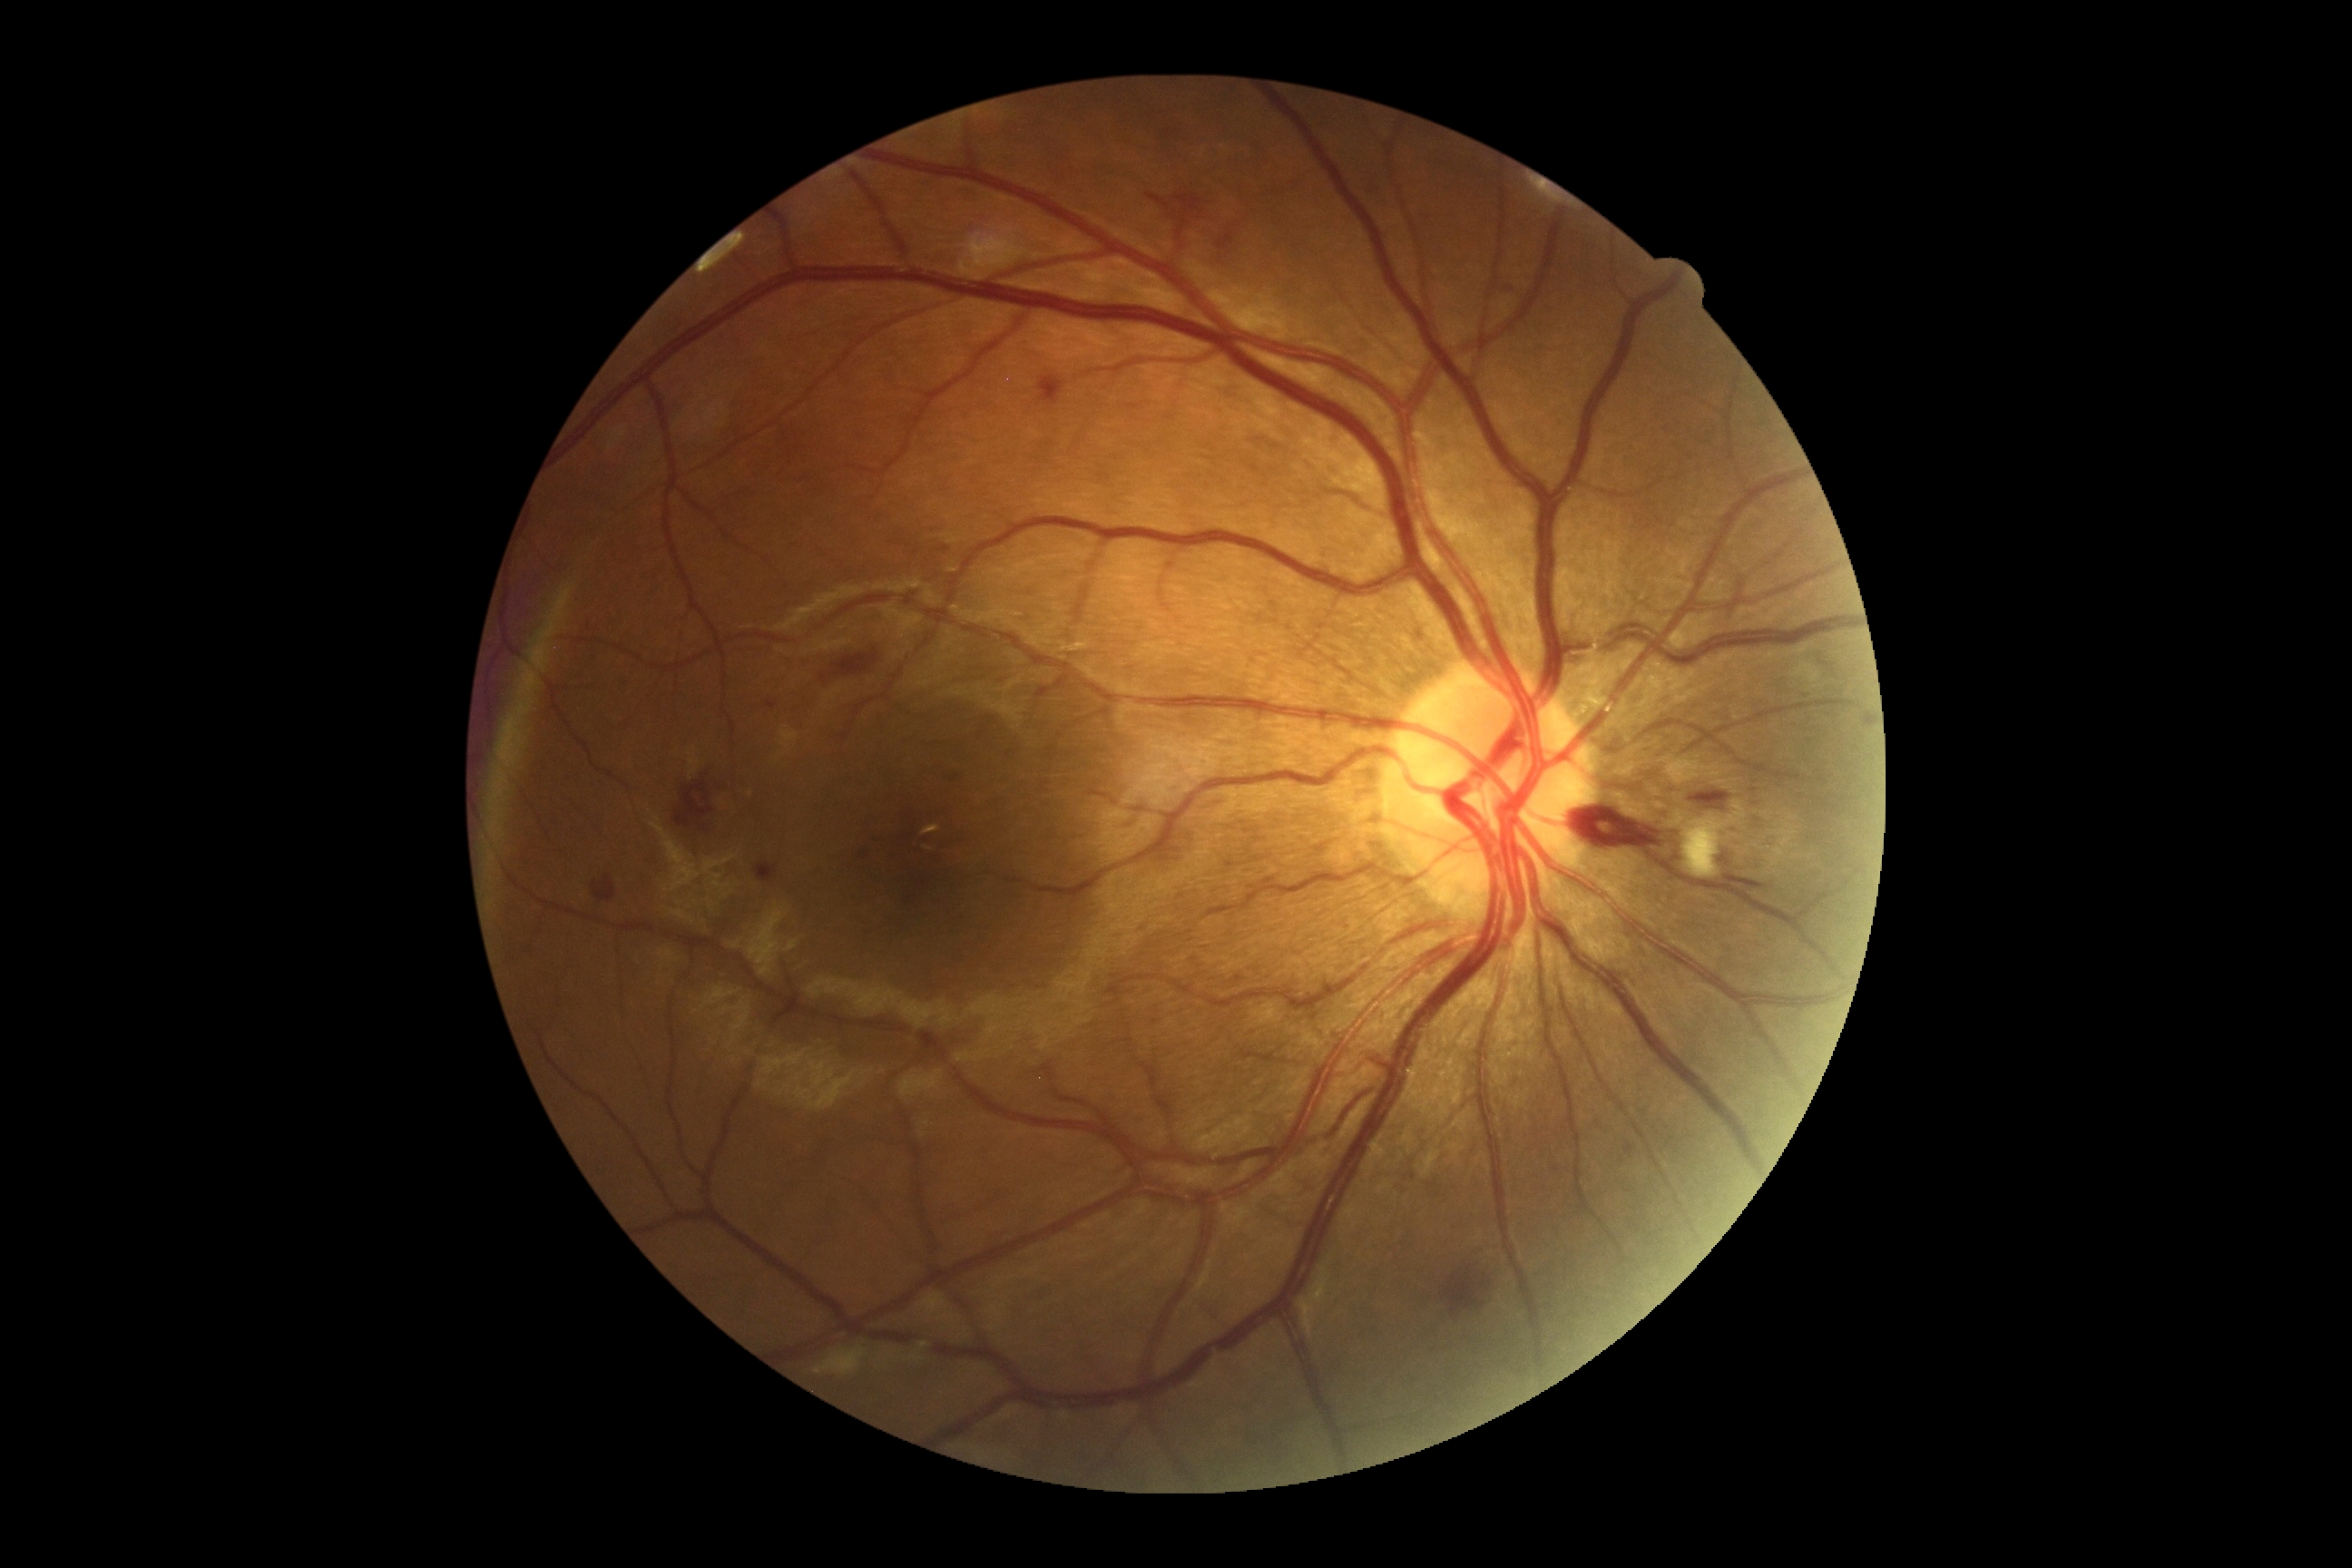
Diabetic retinopathy (DR) is moderate non-proliferative diabetic retinopathy (grade 2).